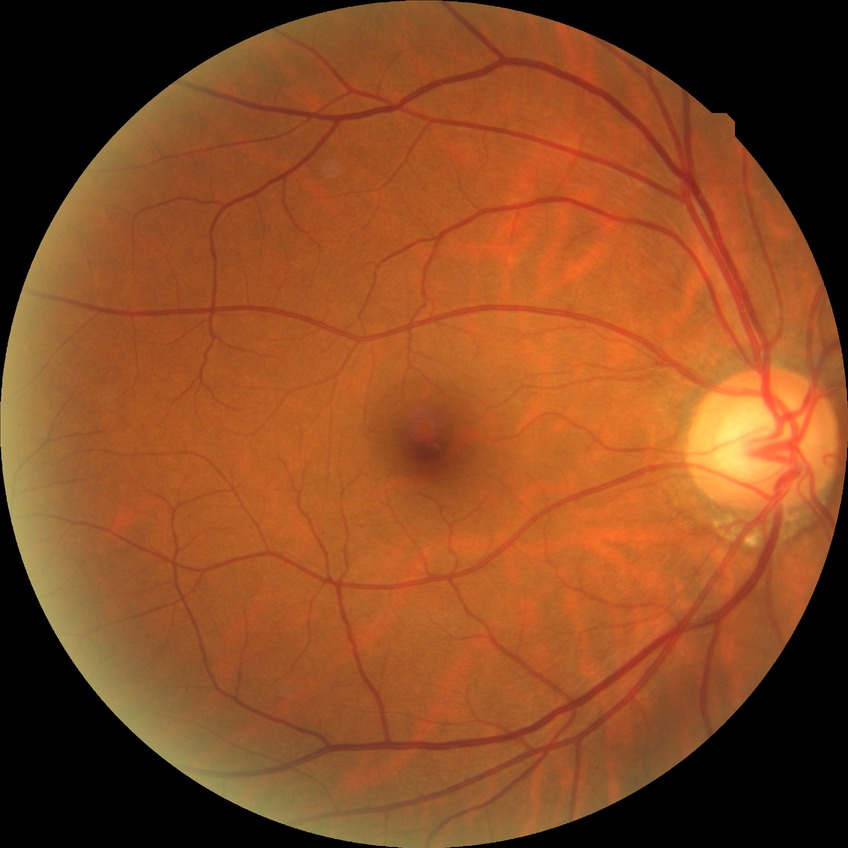 Diabetic retinopathy (DR) is NDR (no diabetic retinopathy).